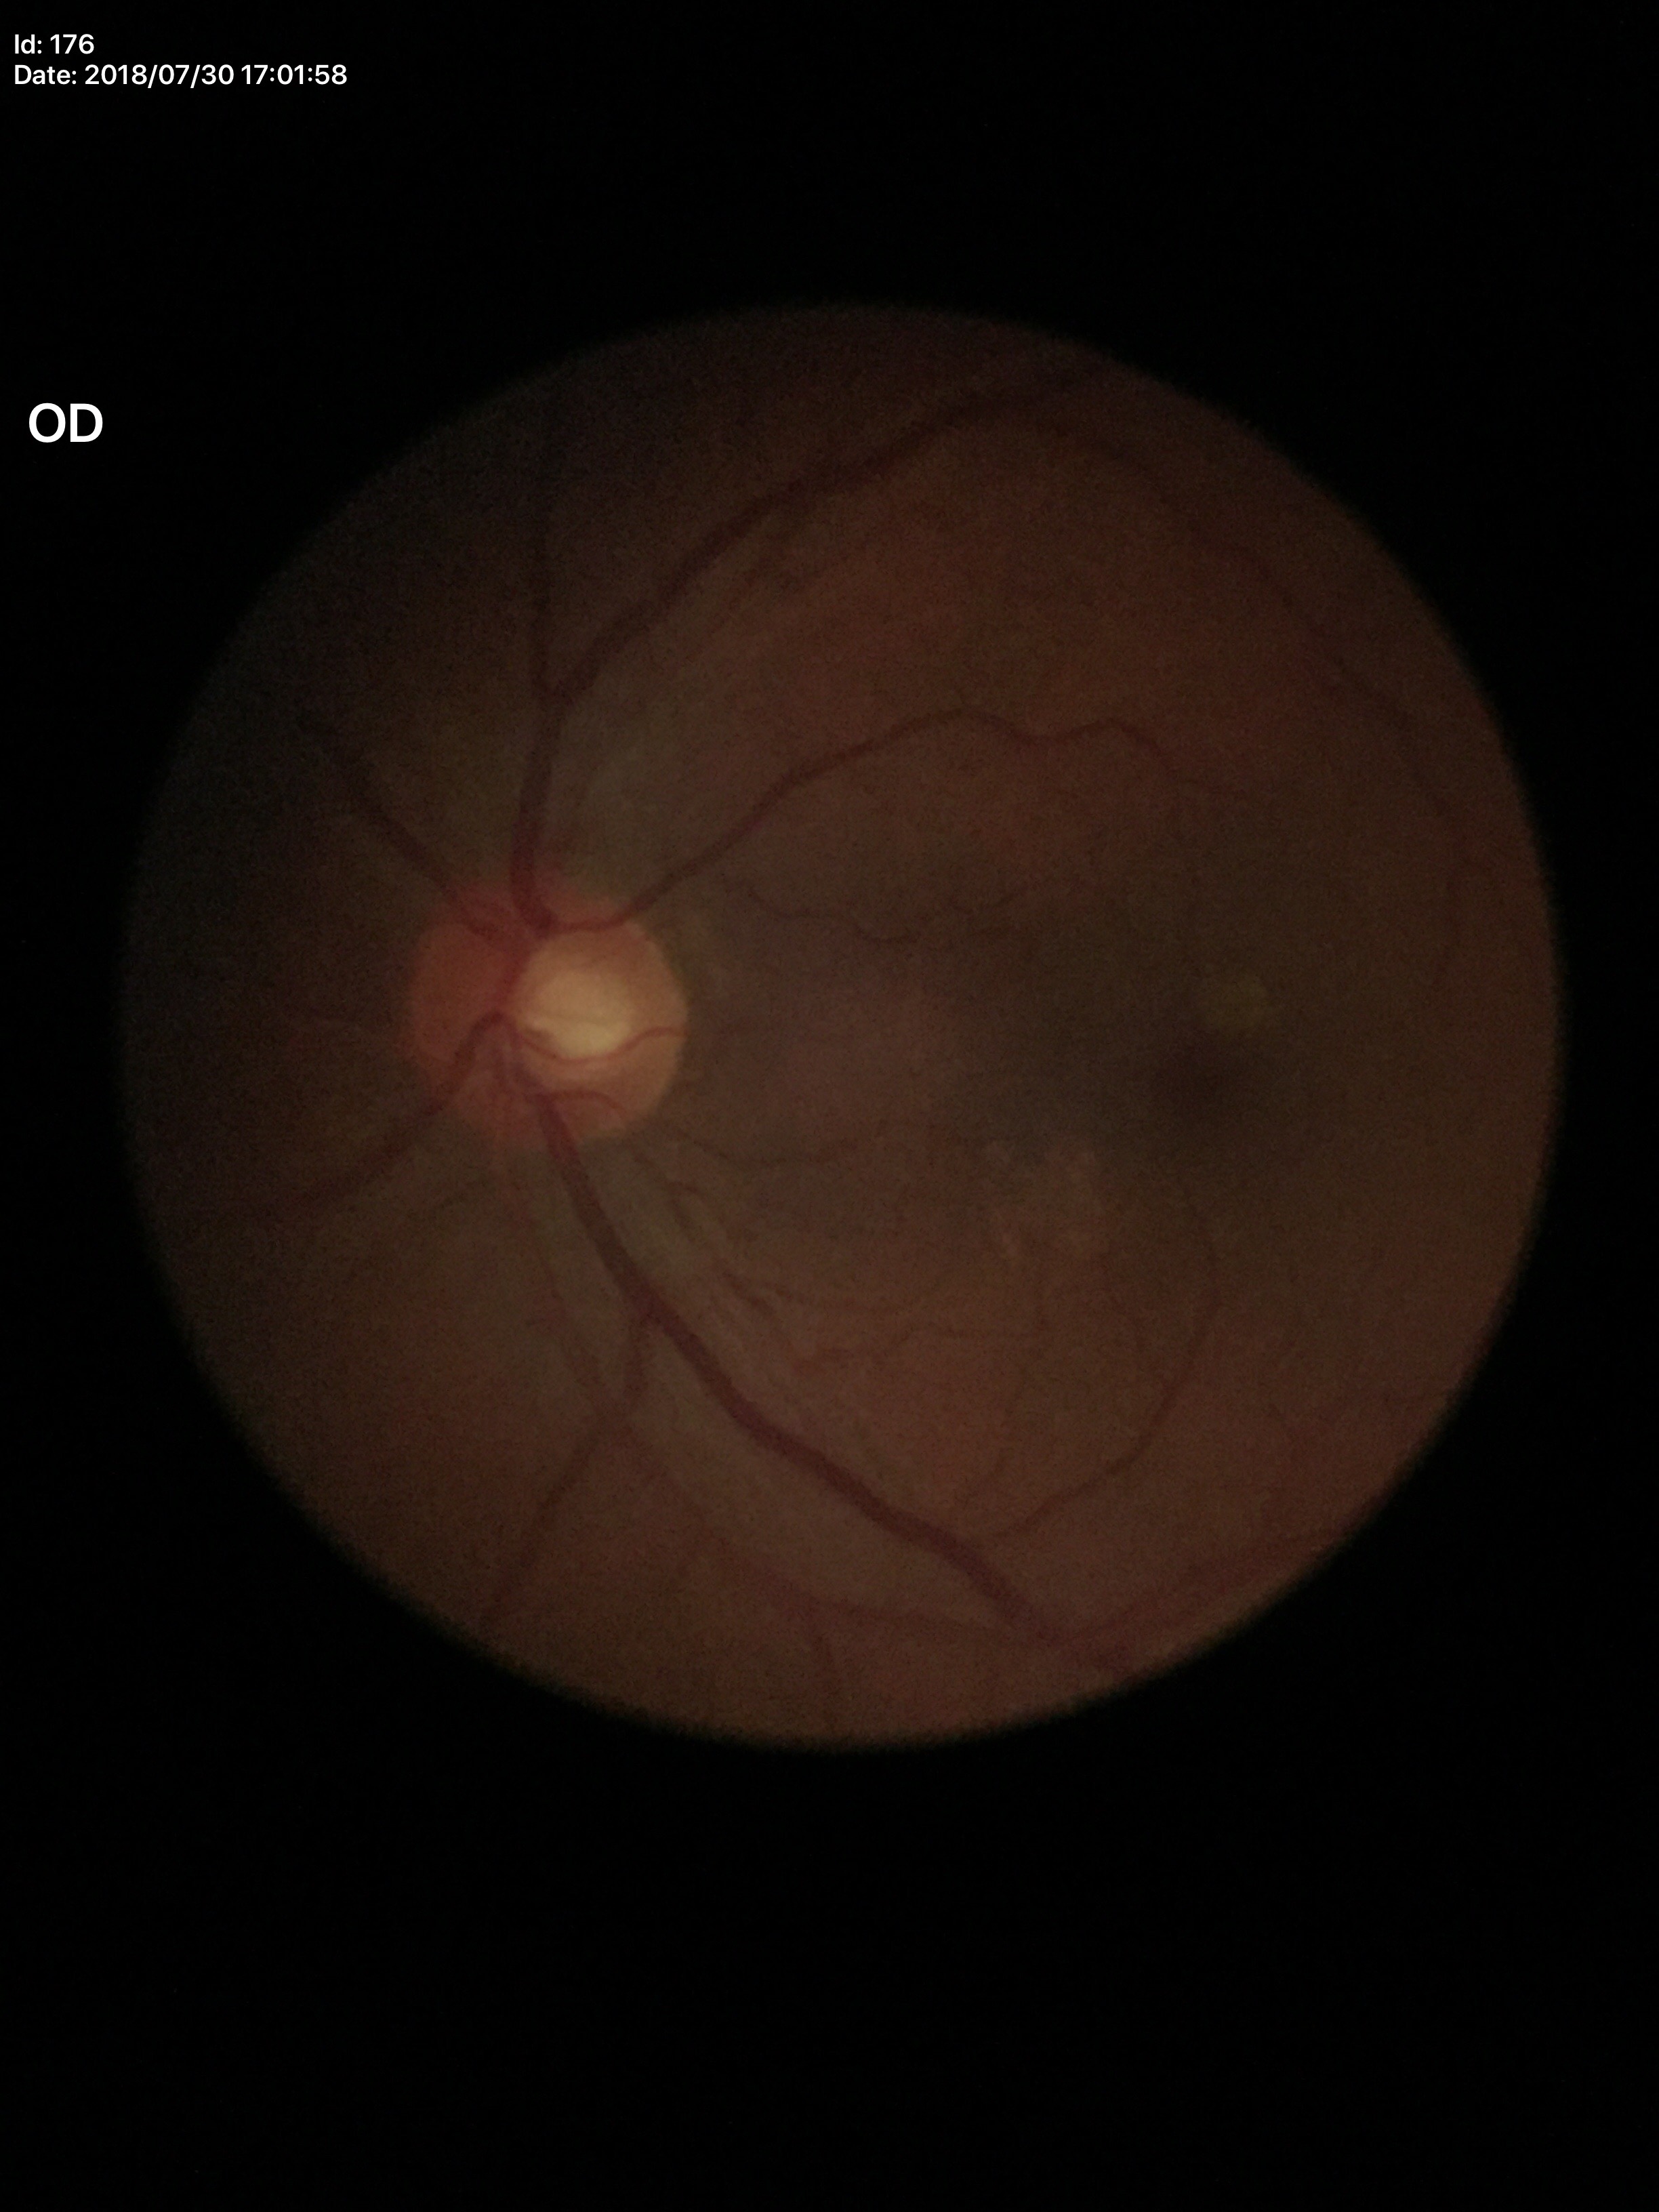

No glaucomatous findings. Vertical cup-to-disc ratio: 0.55.